Color fundus photograph
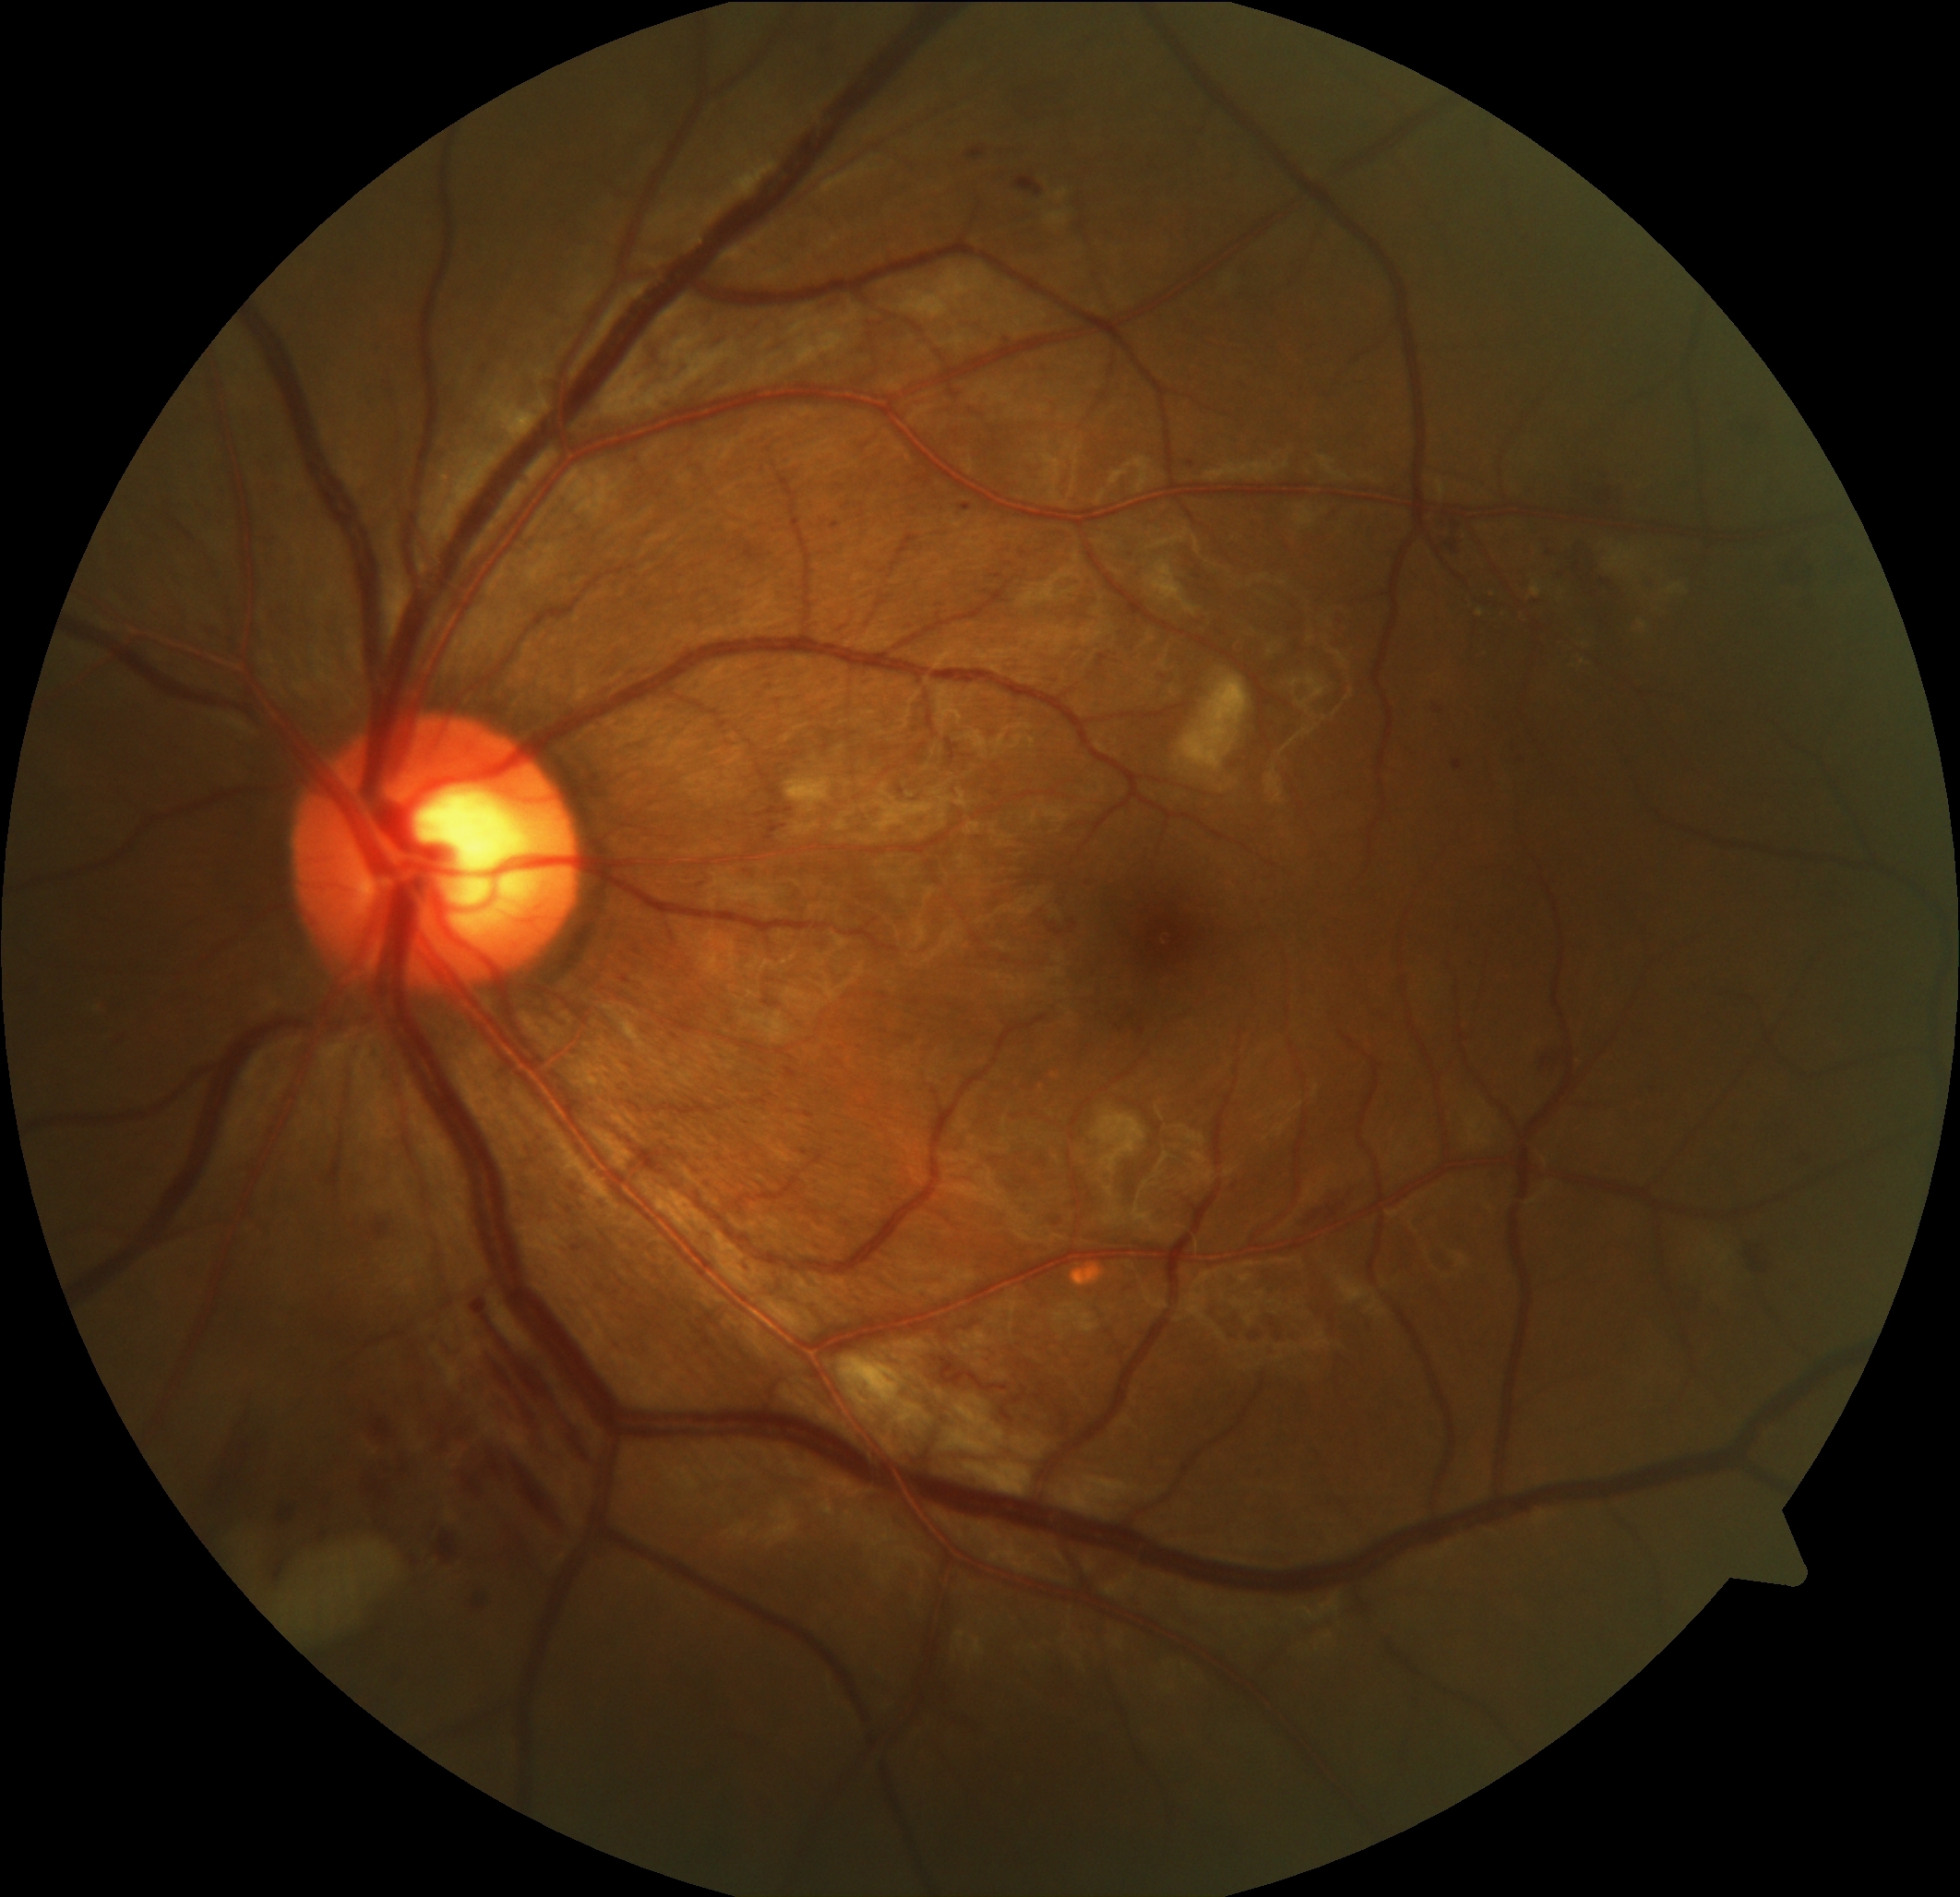 DR class=non-proliferative diabetic retinopathy, diabetic retinopathy (DR)=moderate NPDR (grade 2).